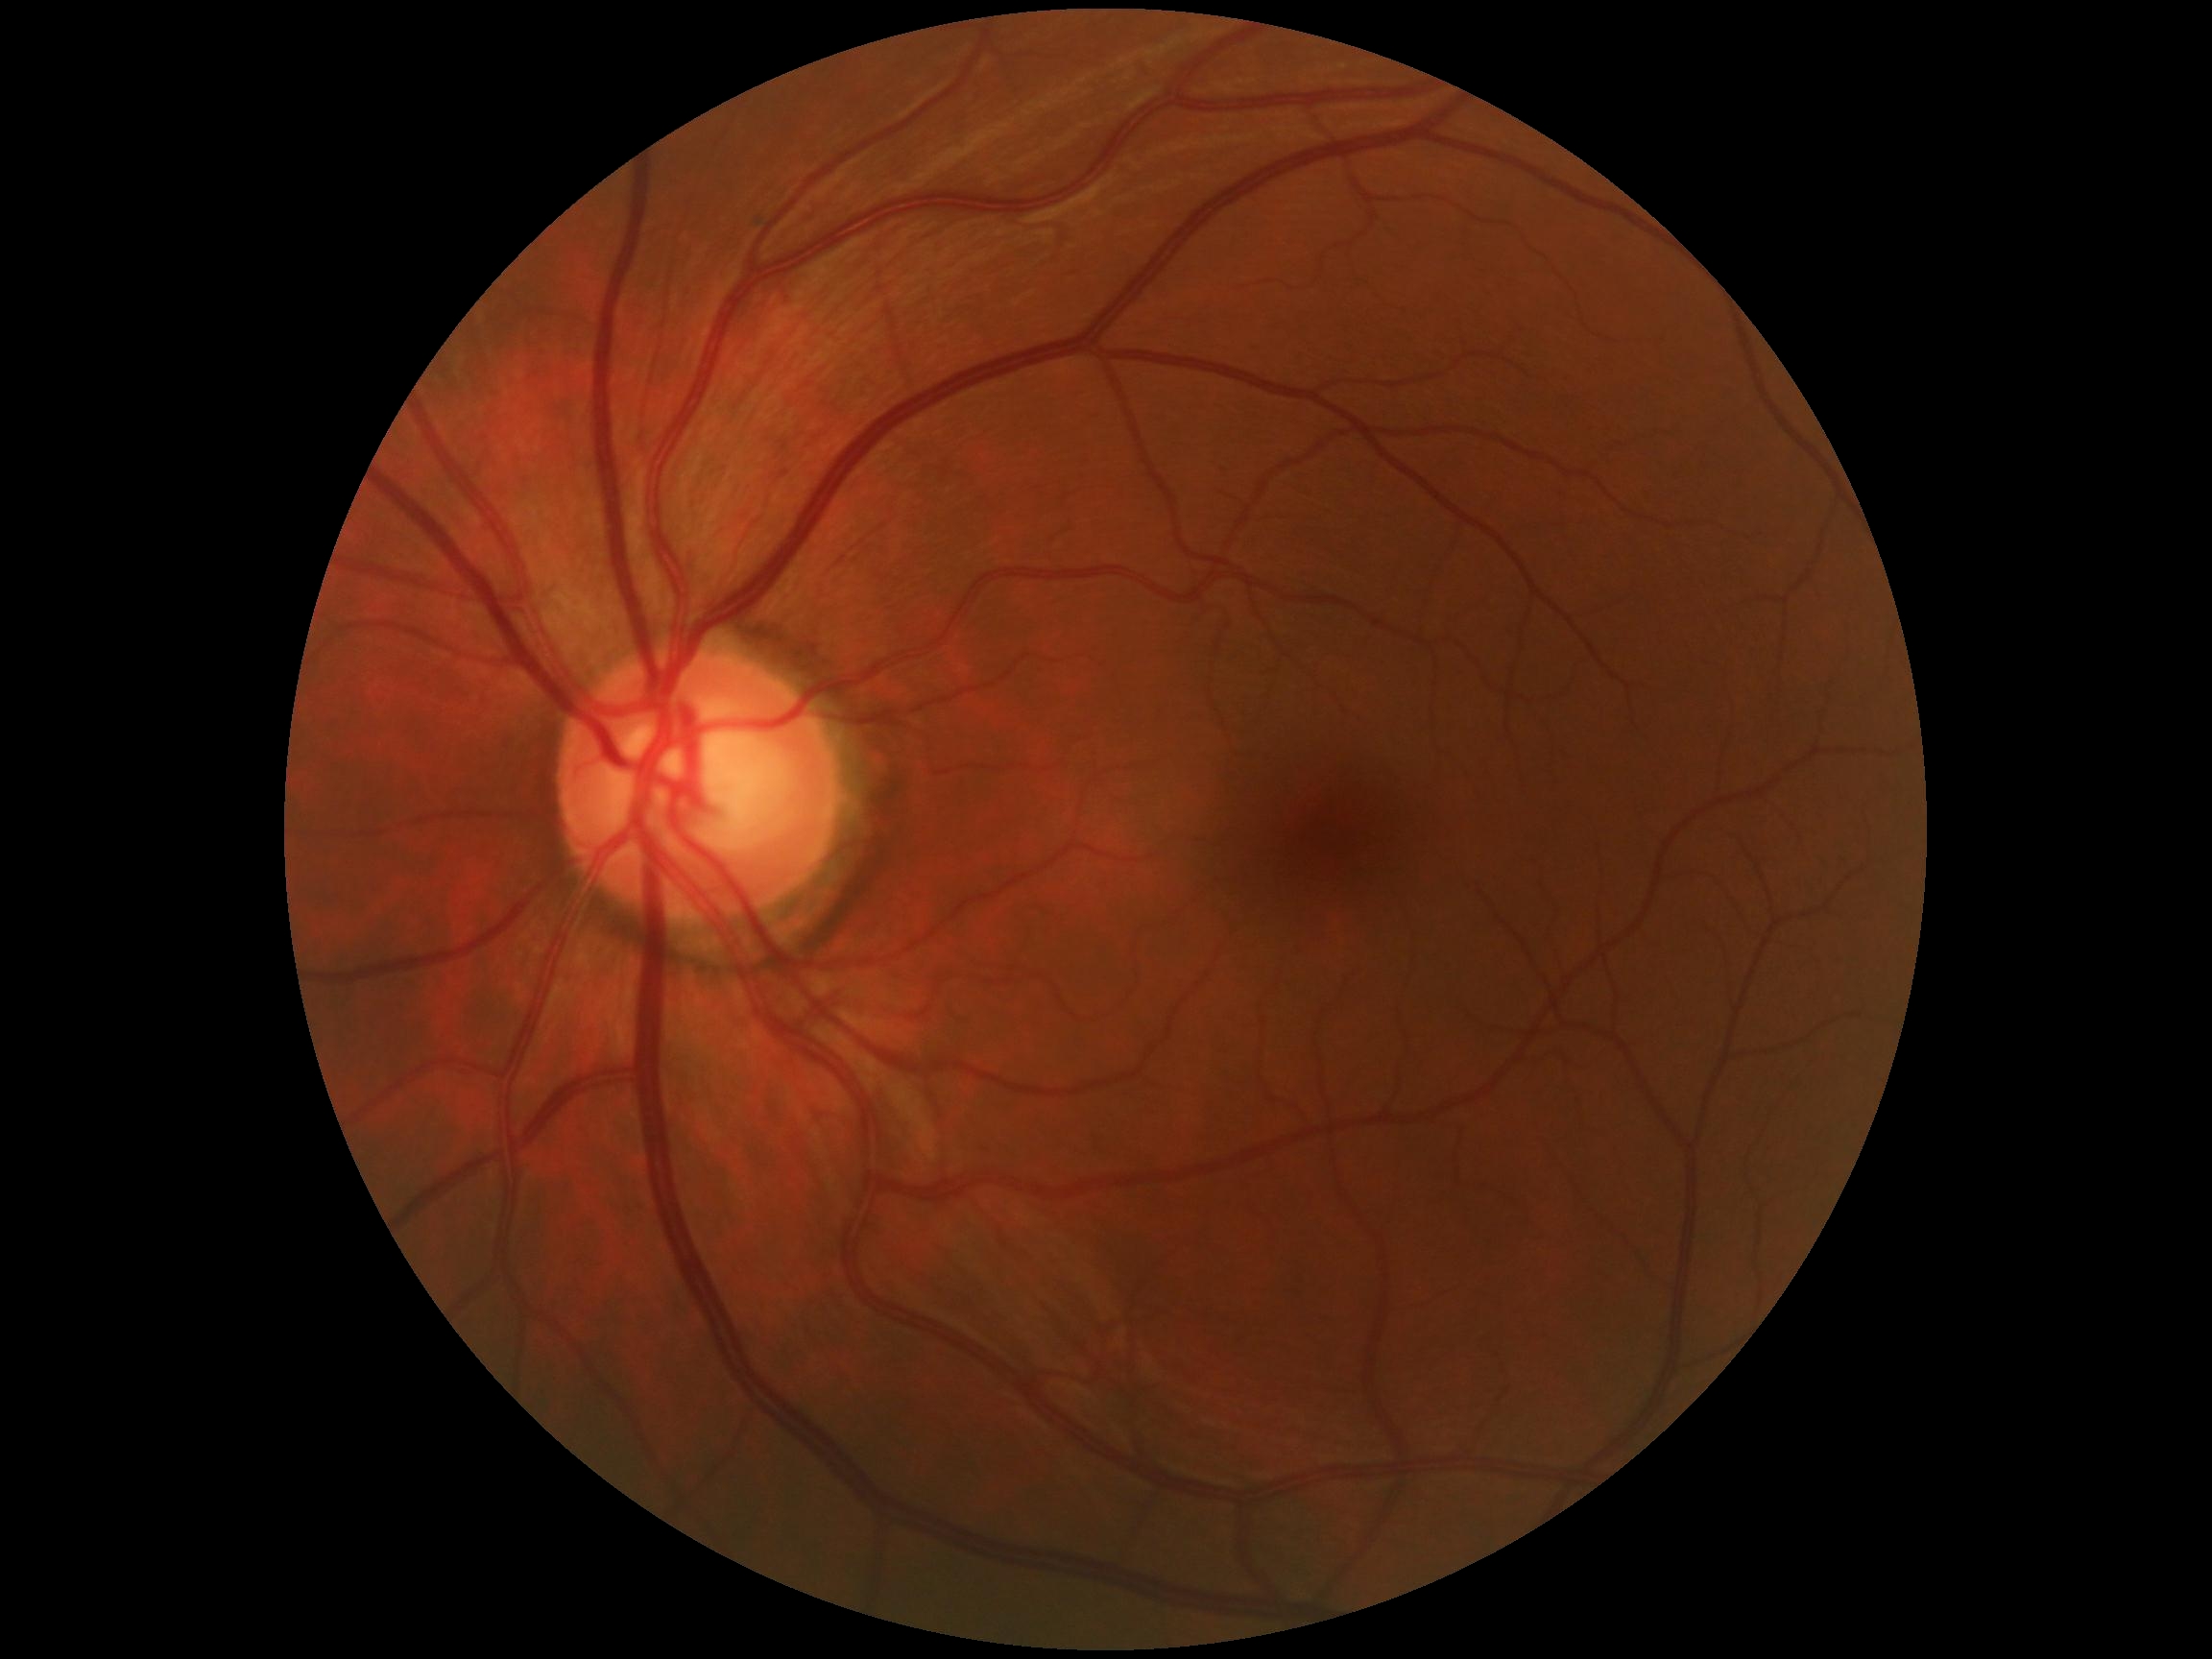
Diabetic retinopathy grade: 0 (no apparent retinopathy).